Image size 640x480. Camera: Clarity RetCam 3 (130° FOV). Wide-field contact fundus photograph of an infant.
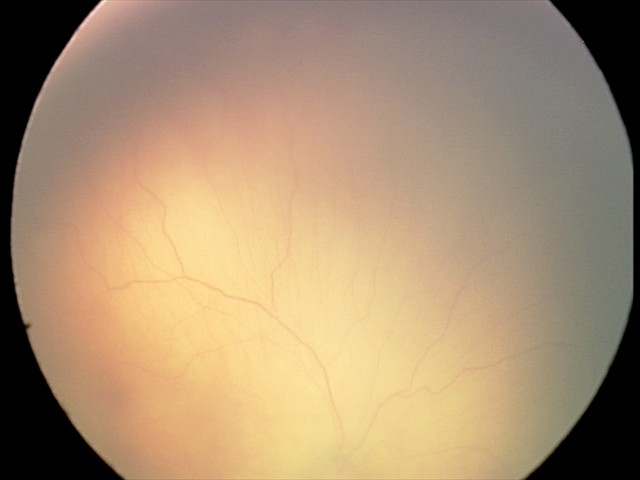
Q: What was the screening finding?
A: ROP stage 1